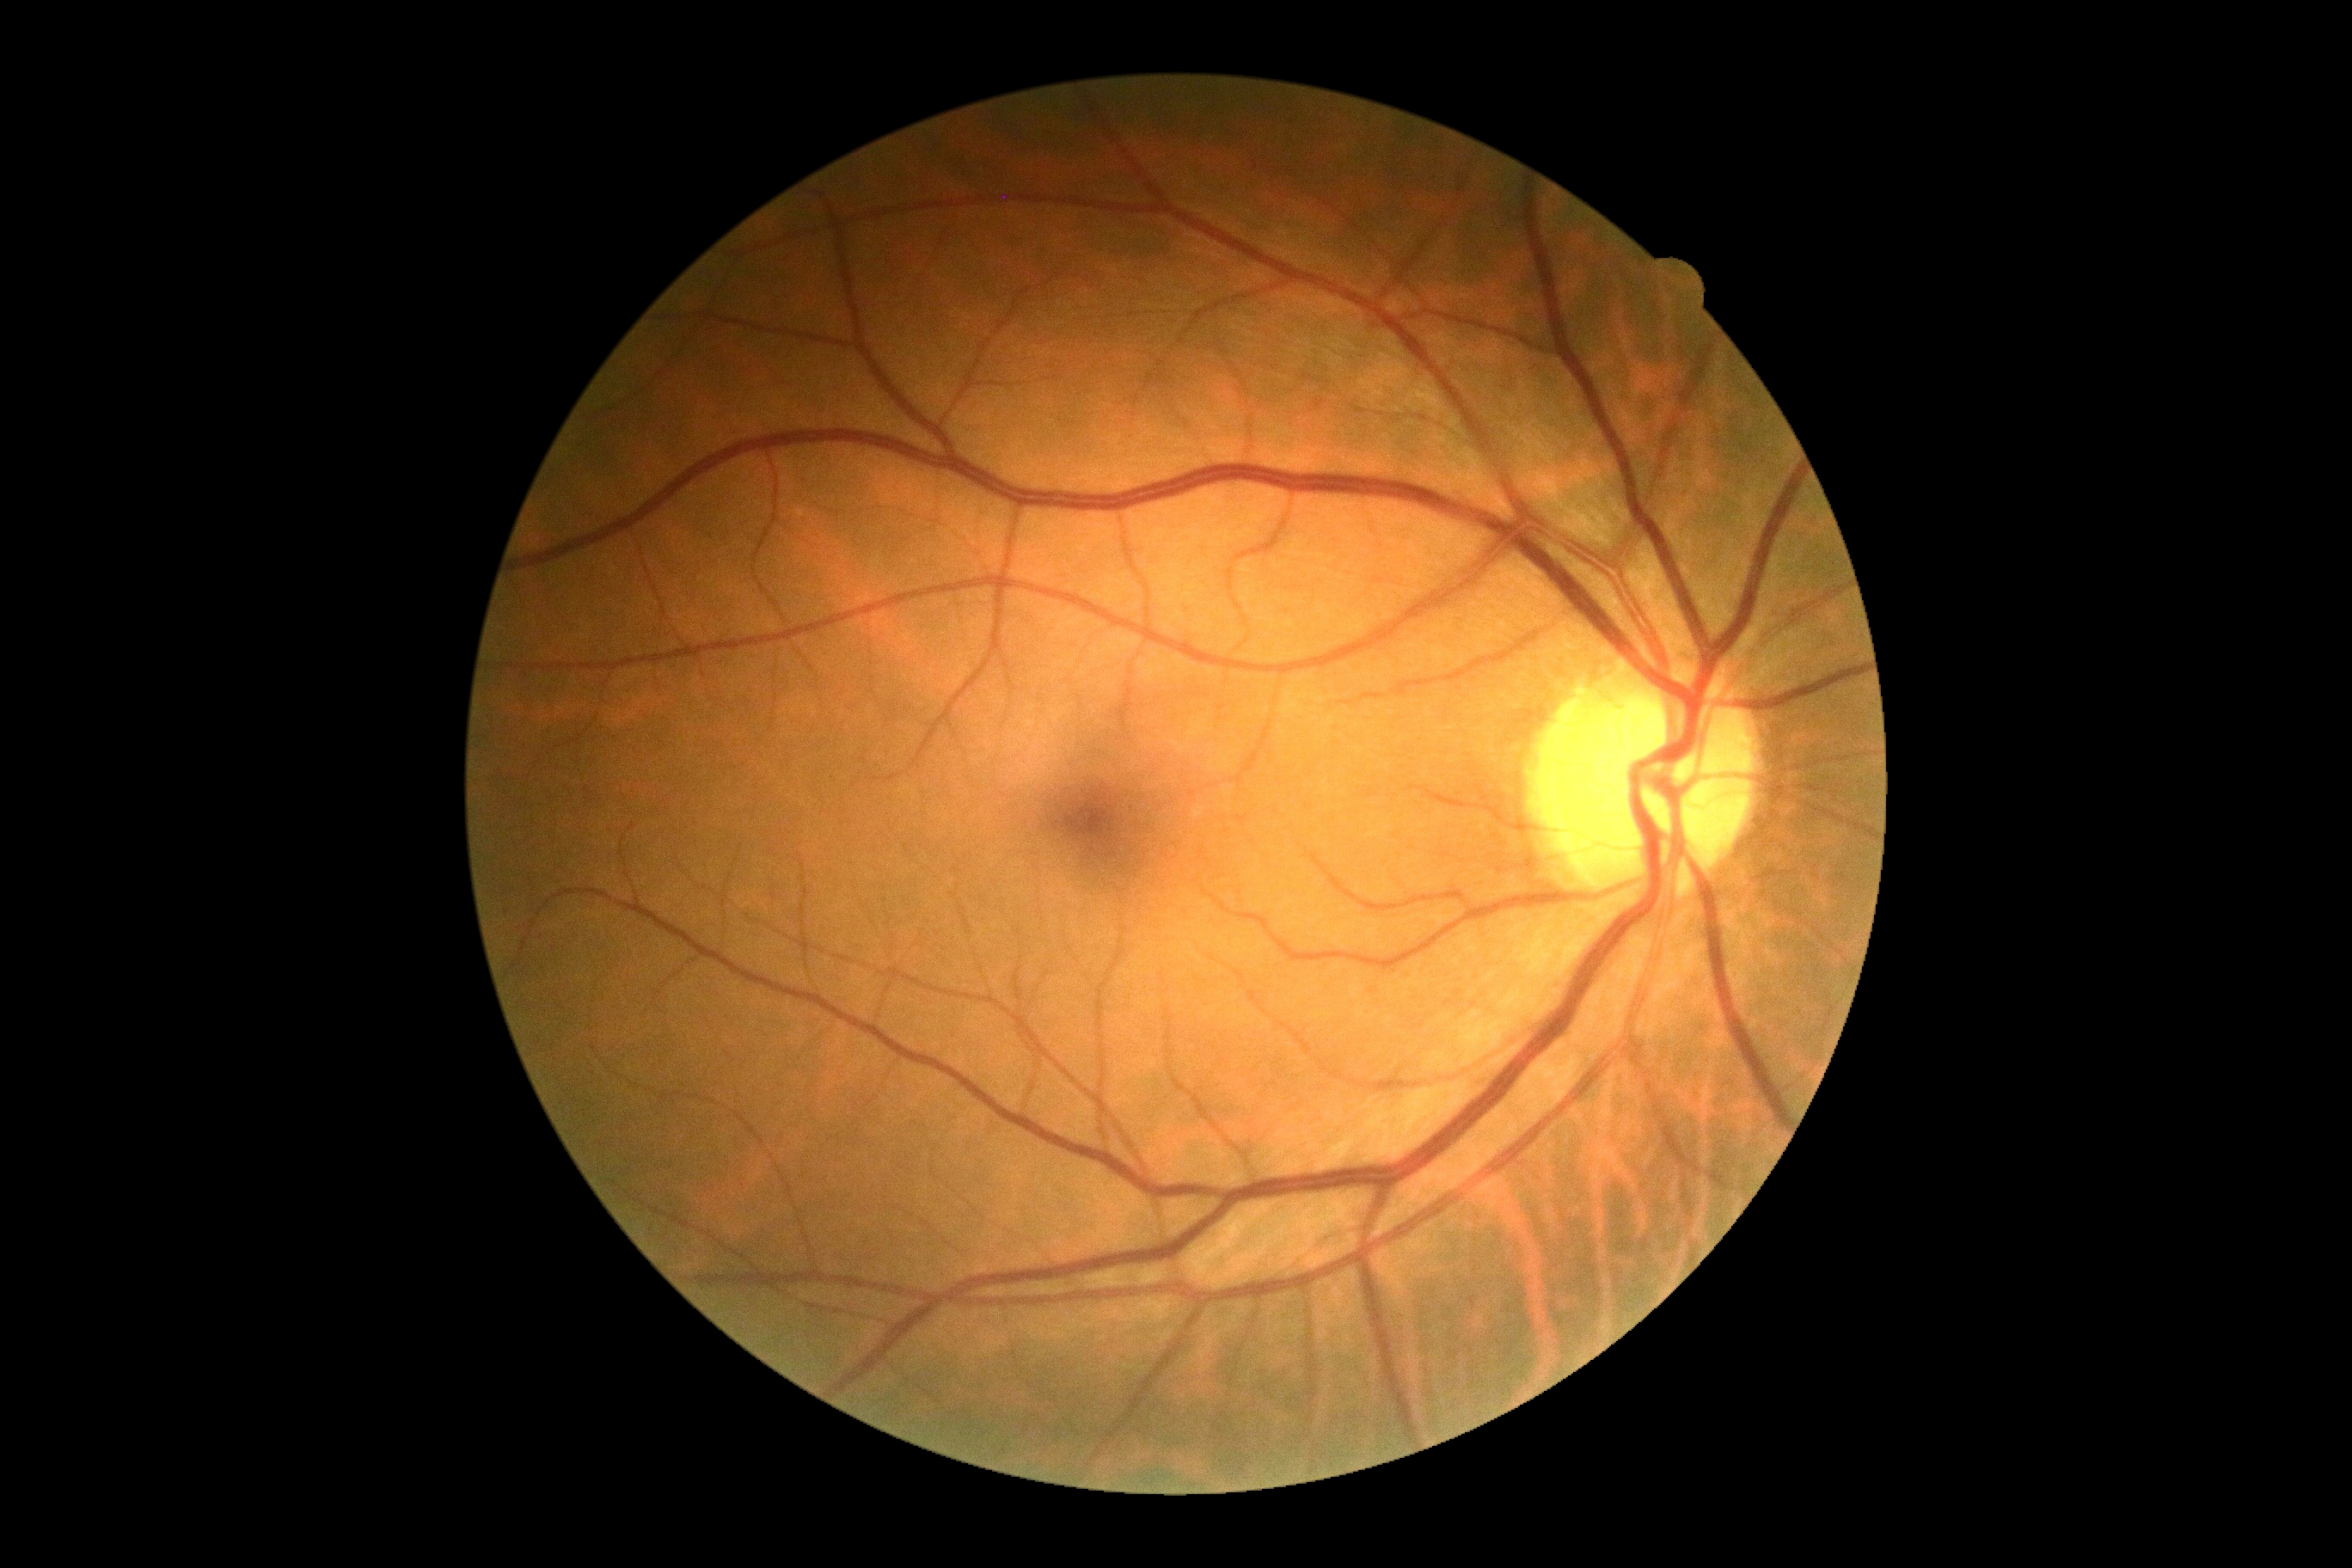
DR stage: 0/4. No DR findings.